Wide-field fundus photograph of an infant · Clarity RetCam 3, 130° FOV.
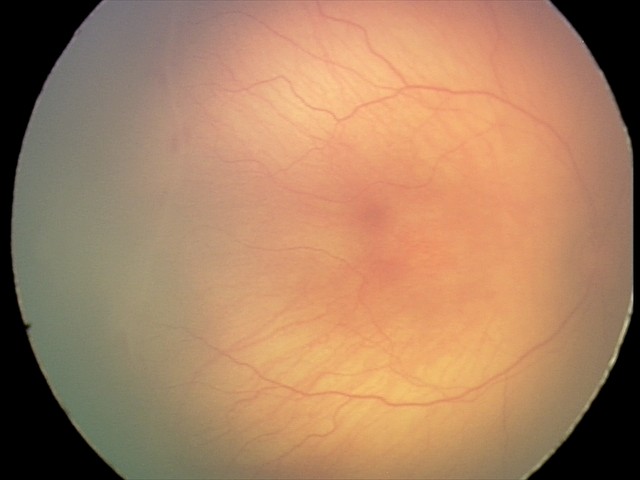 Without plus disease.
From an examination with diagnosis of retinopathy of prematurity stage 1.